Modified Davis classification, 848 by 848 pixels: 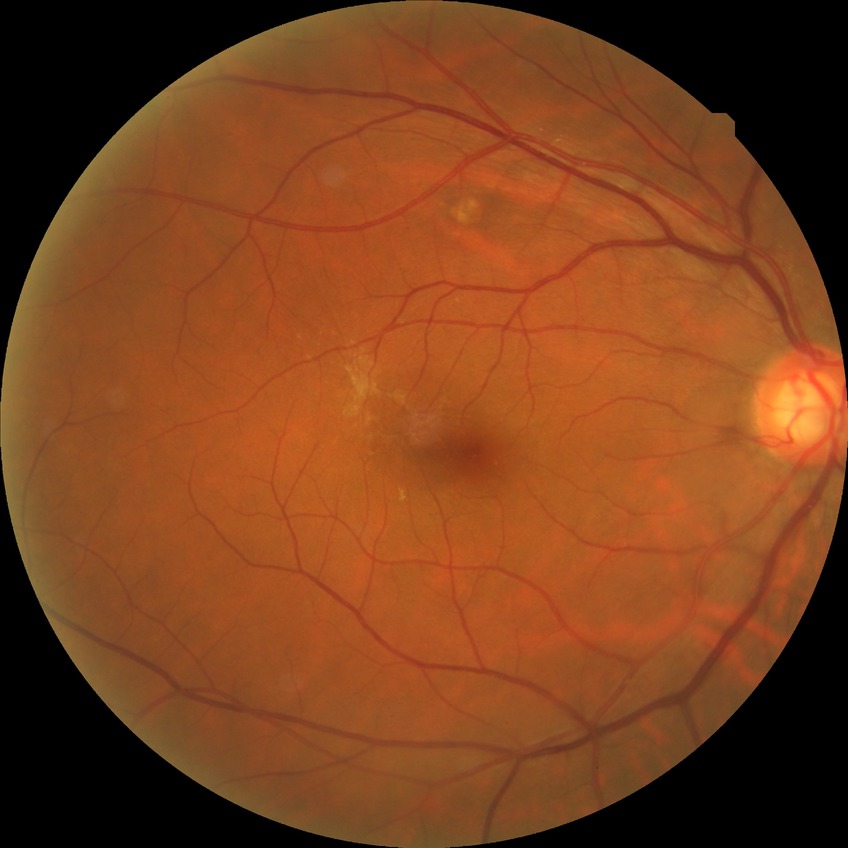
  davis_grade: no diabetic retinopathy